45-degree field of view.
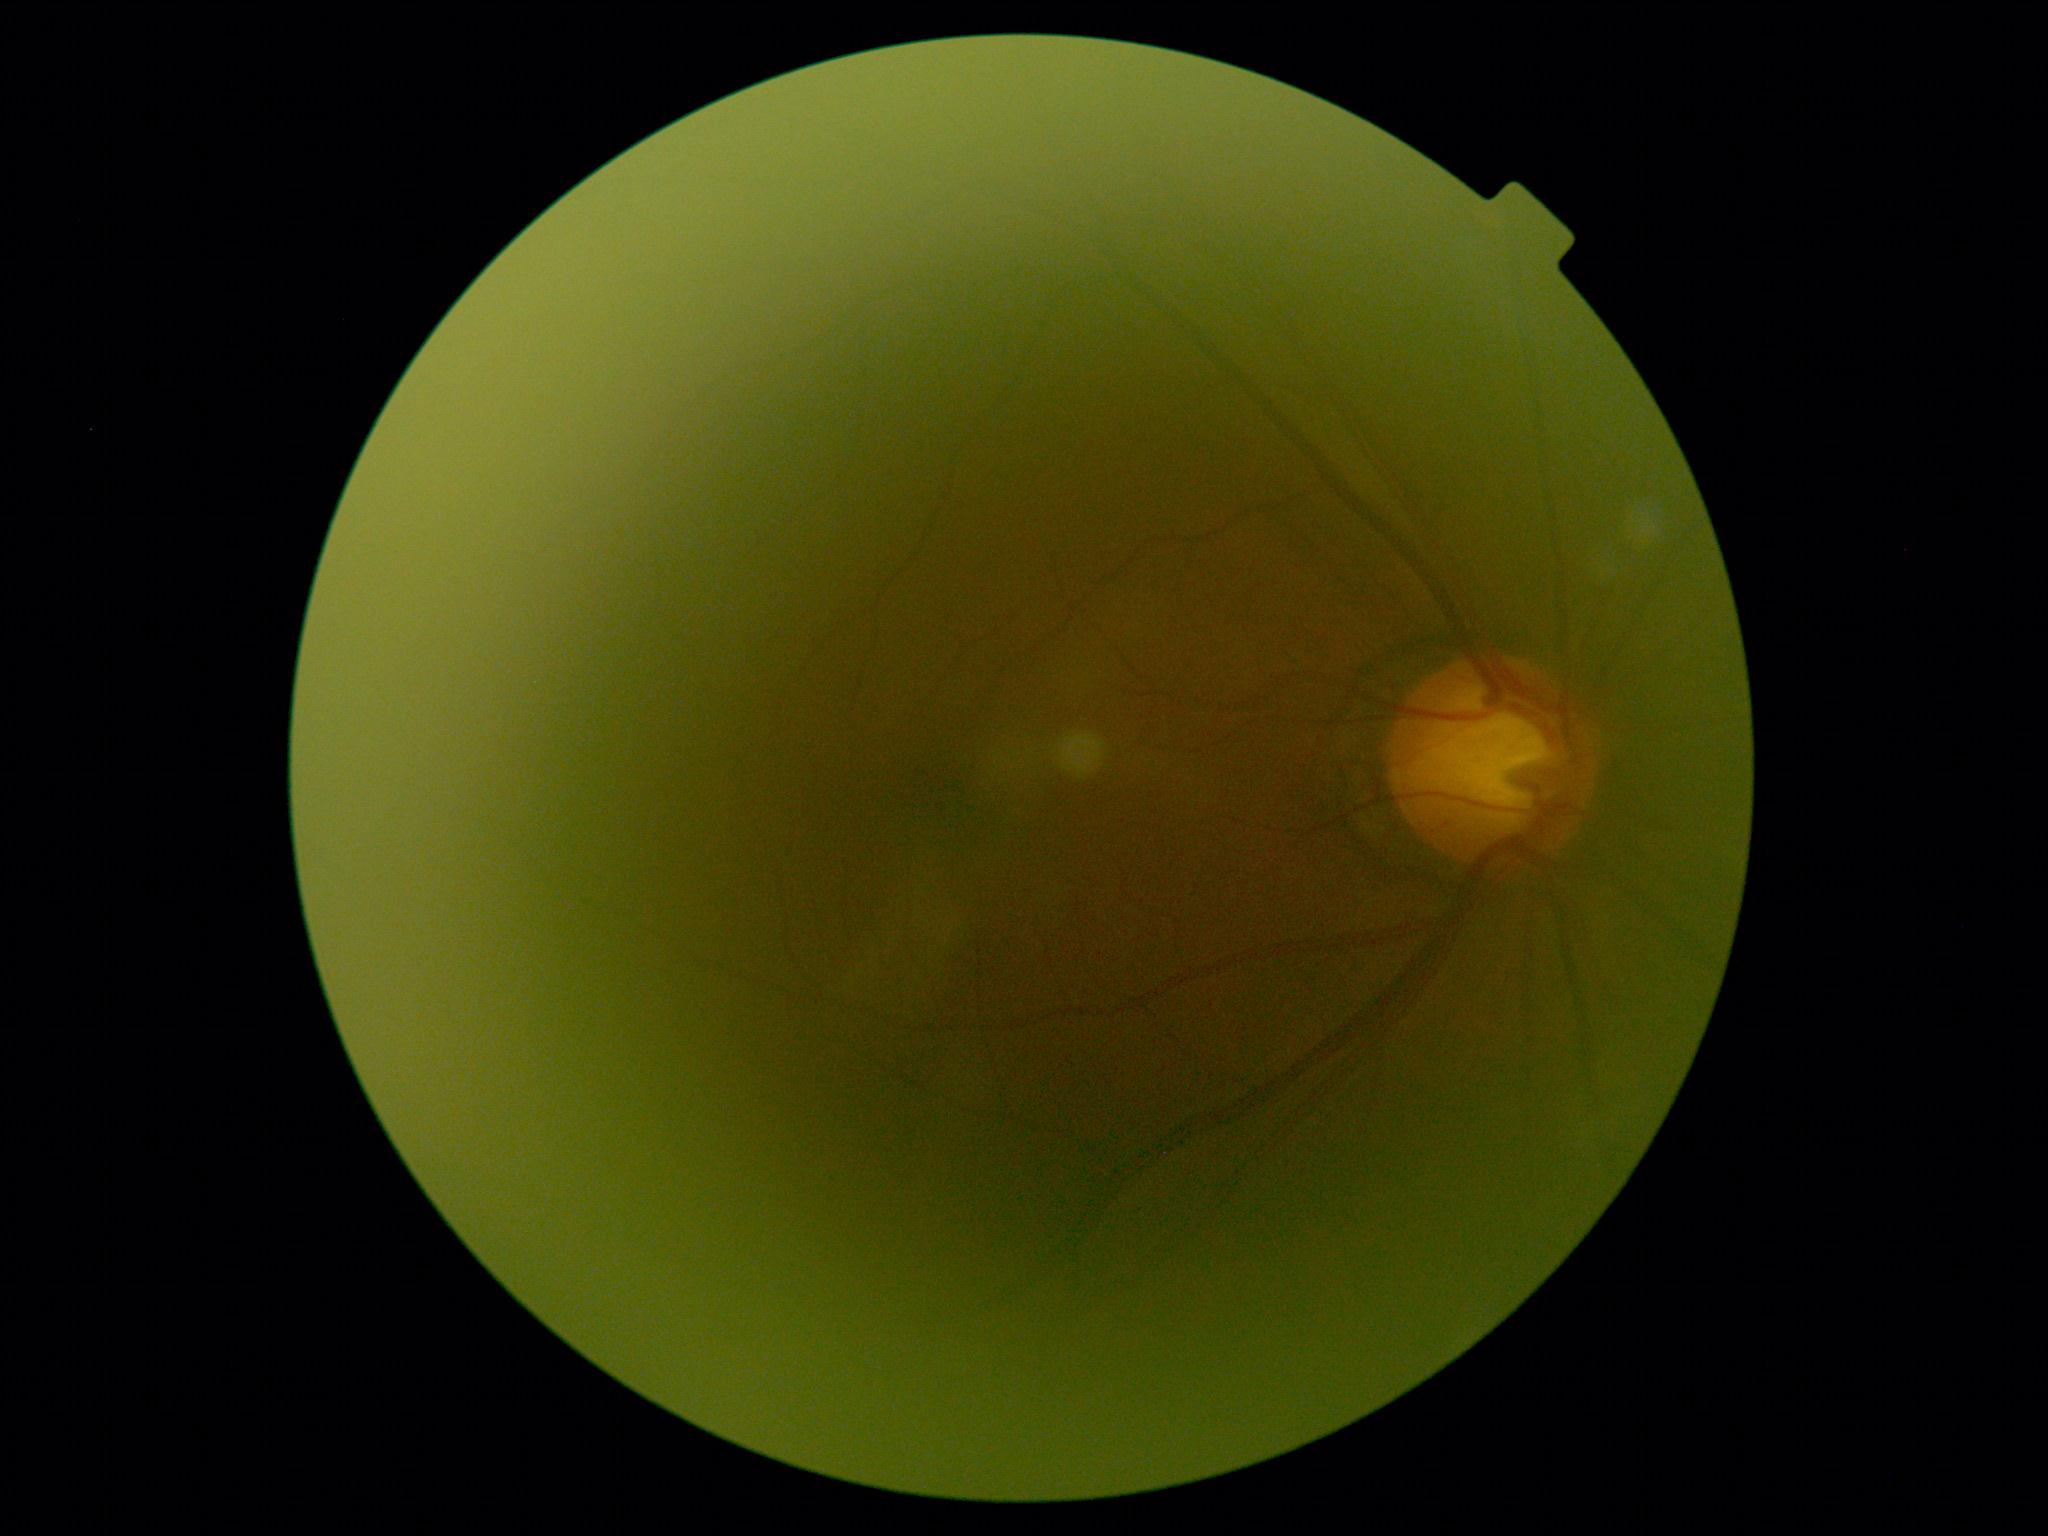 Annotations:
* DR — 0